Modified Davis grading: 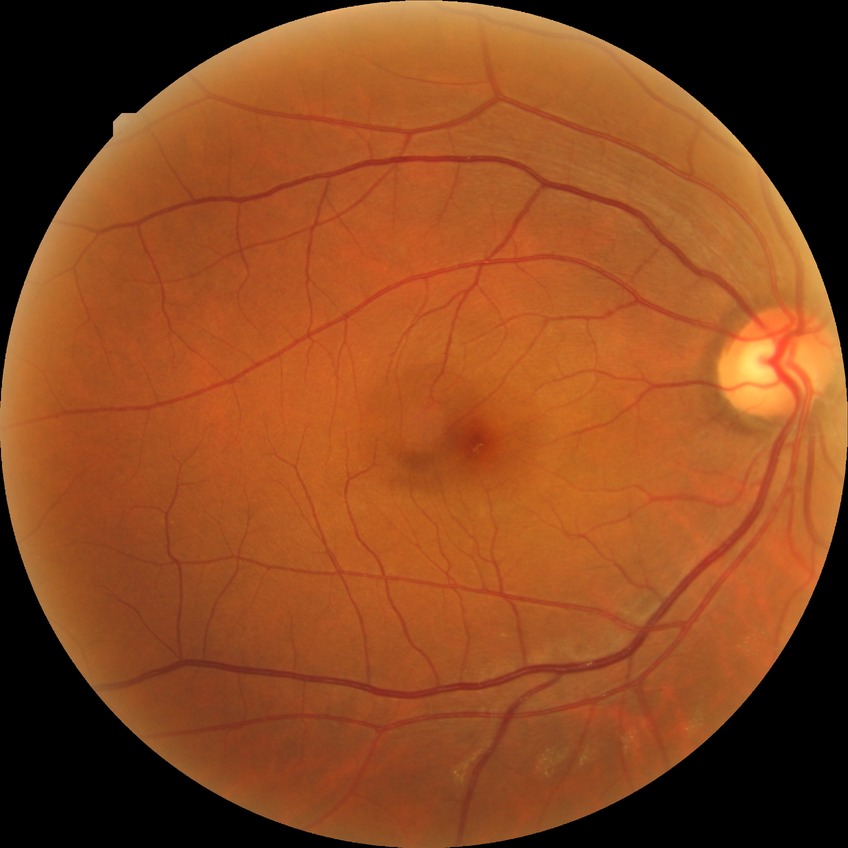

diabetic retinopathy (DR): NDR (no diabetic retinopathy).